Acquired on the Phoenix ICON. Wide-field fundus photograph of an infant — 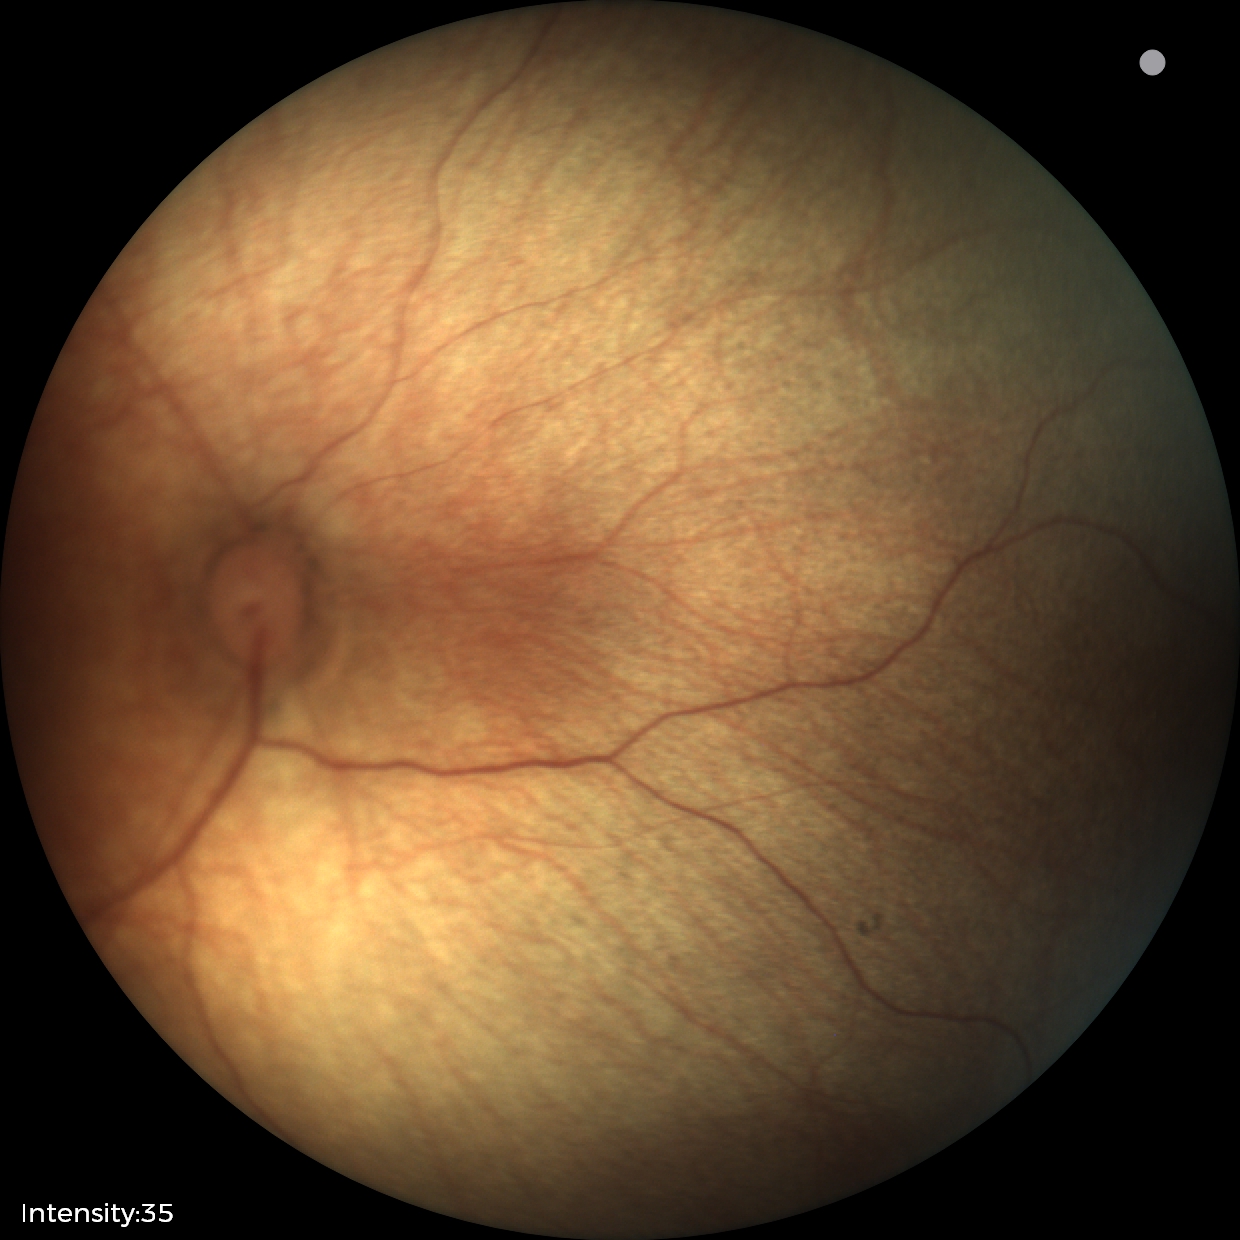

No retinal pathology identified on screening.